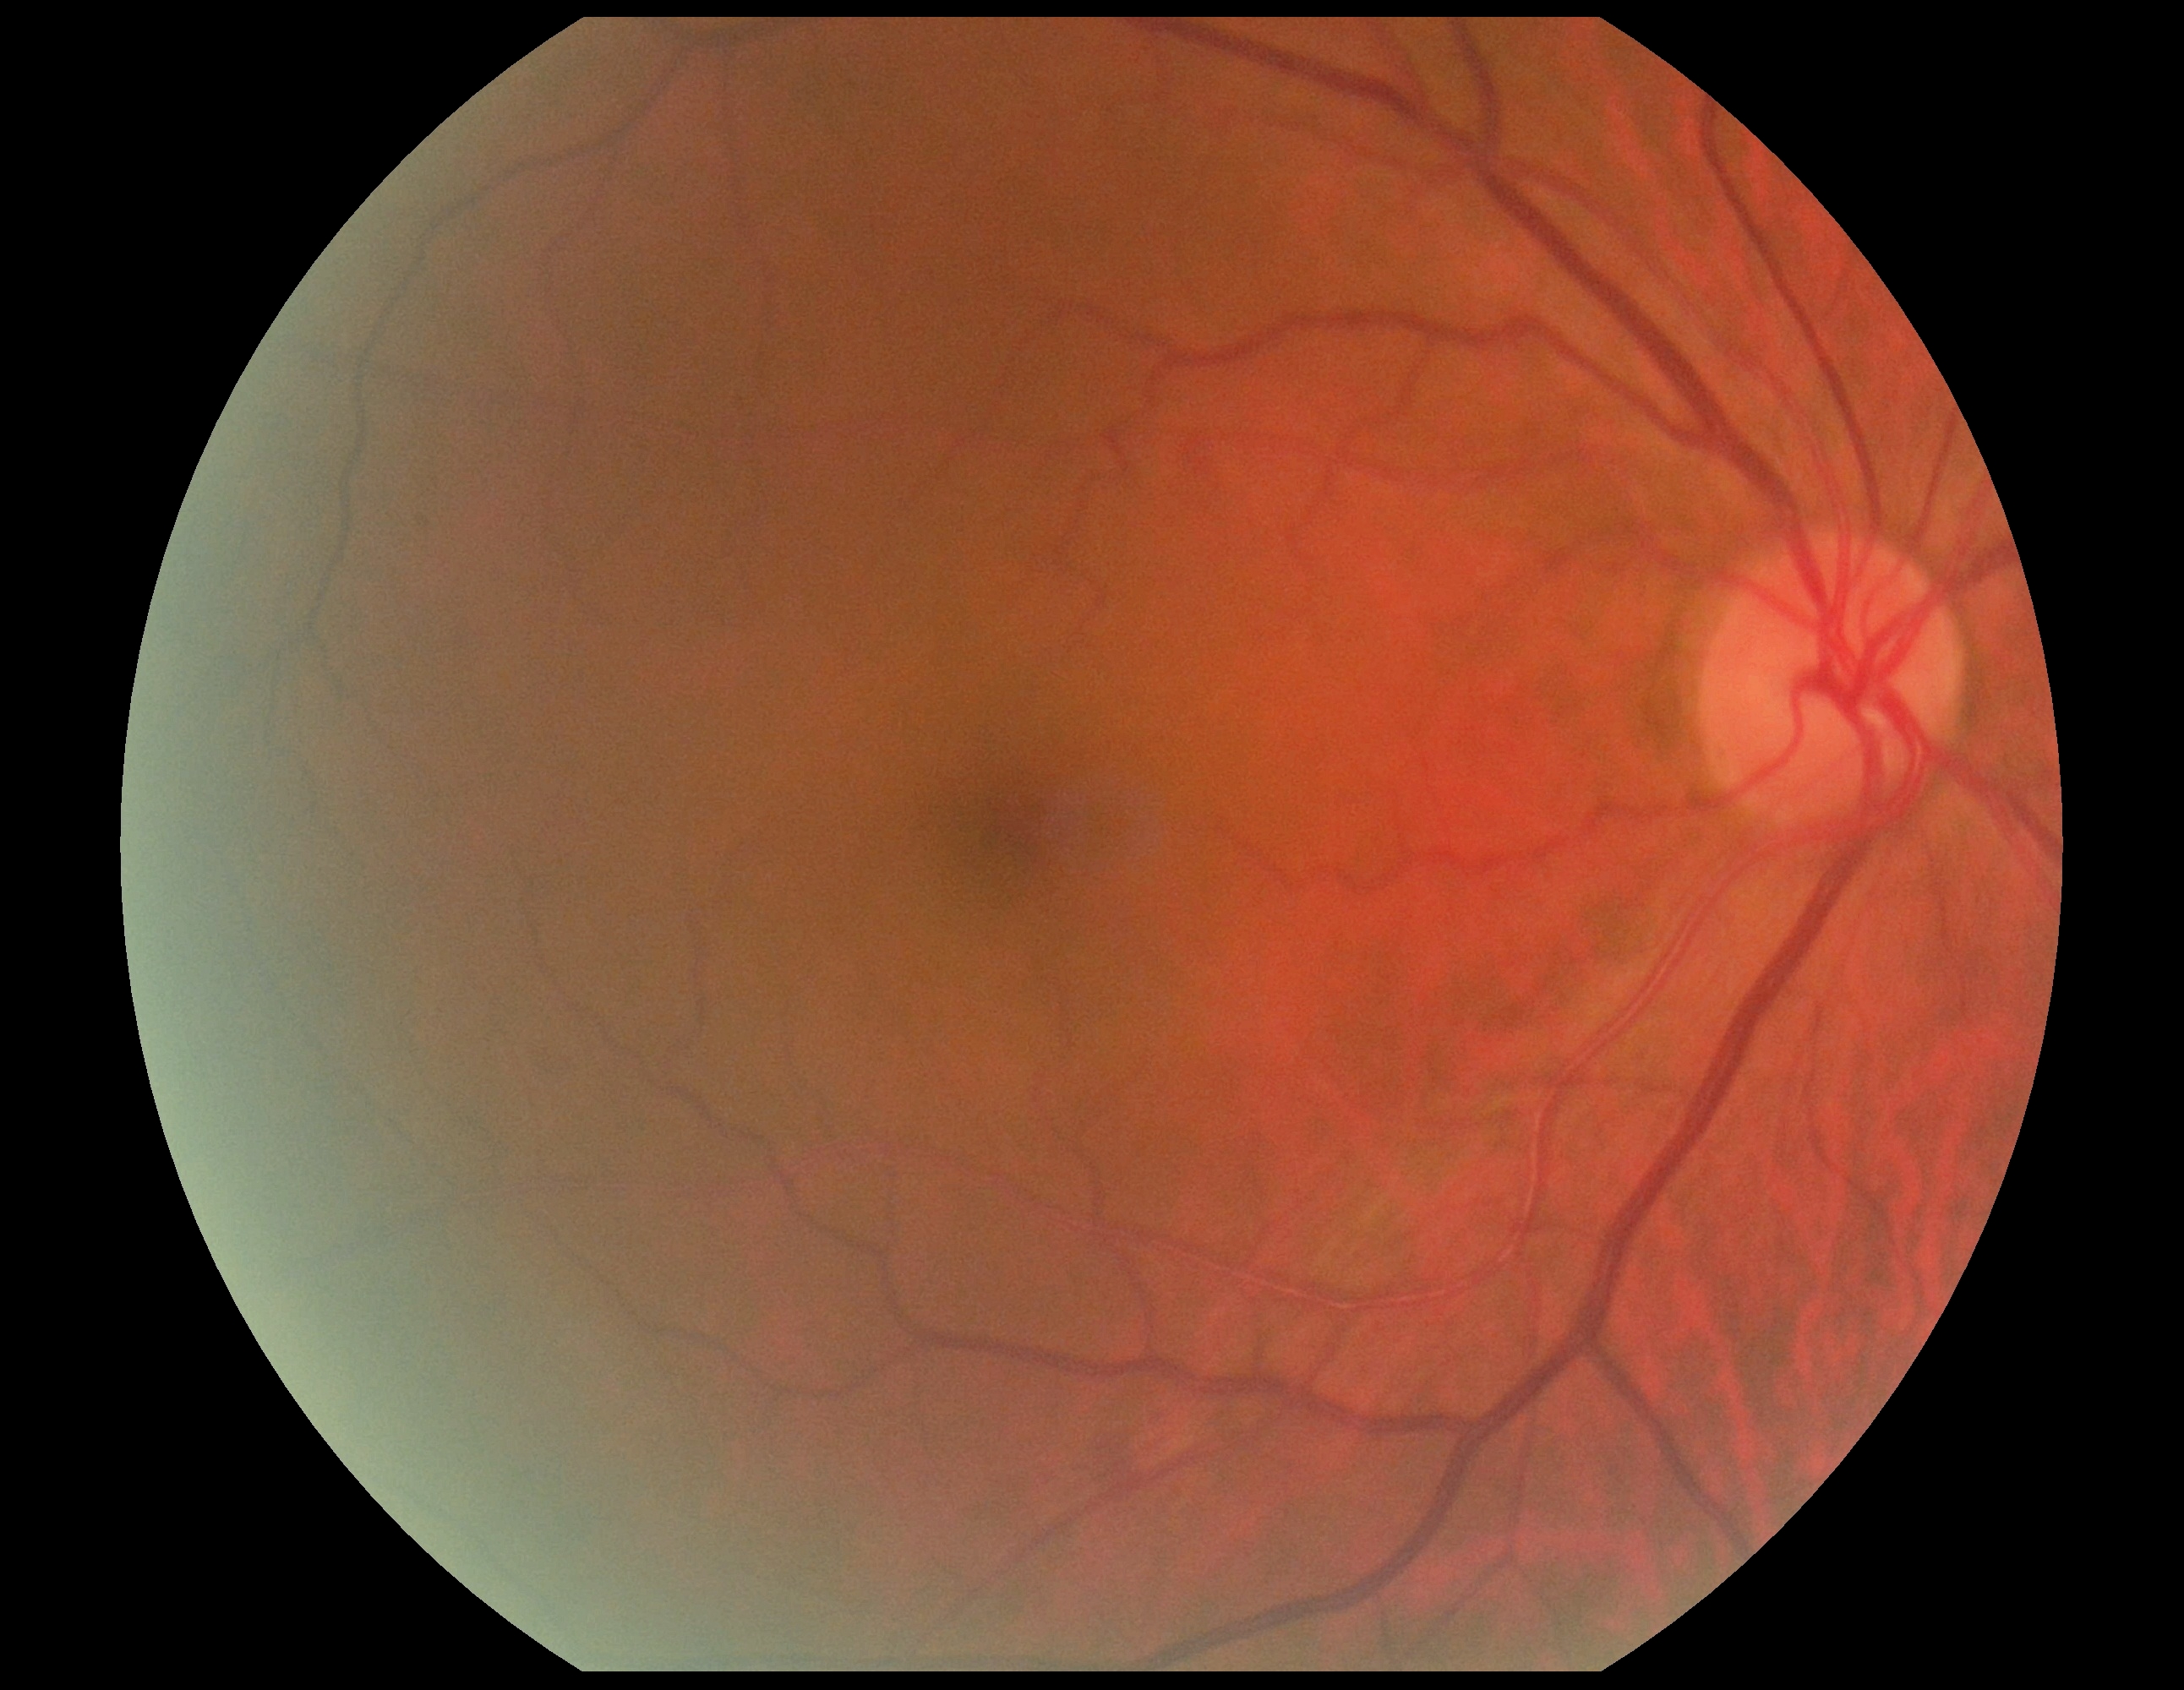

Diabetic retinopathy is 2/4.